45-degree field of view.
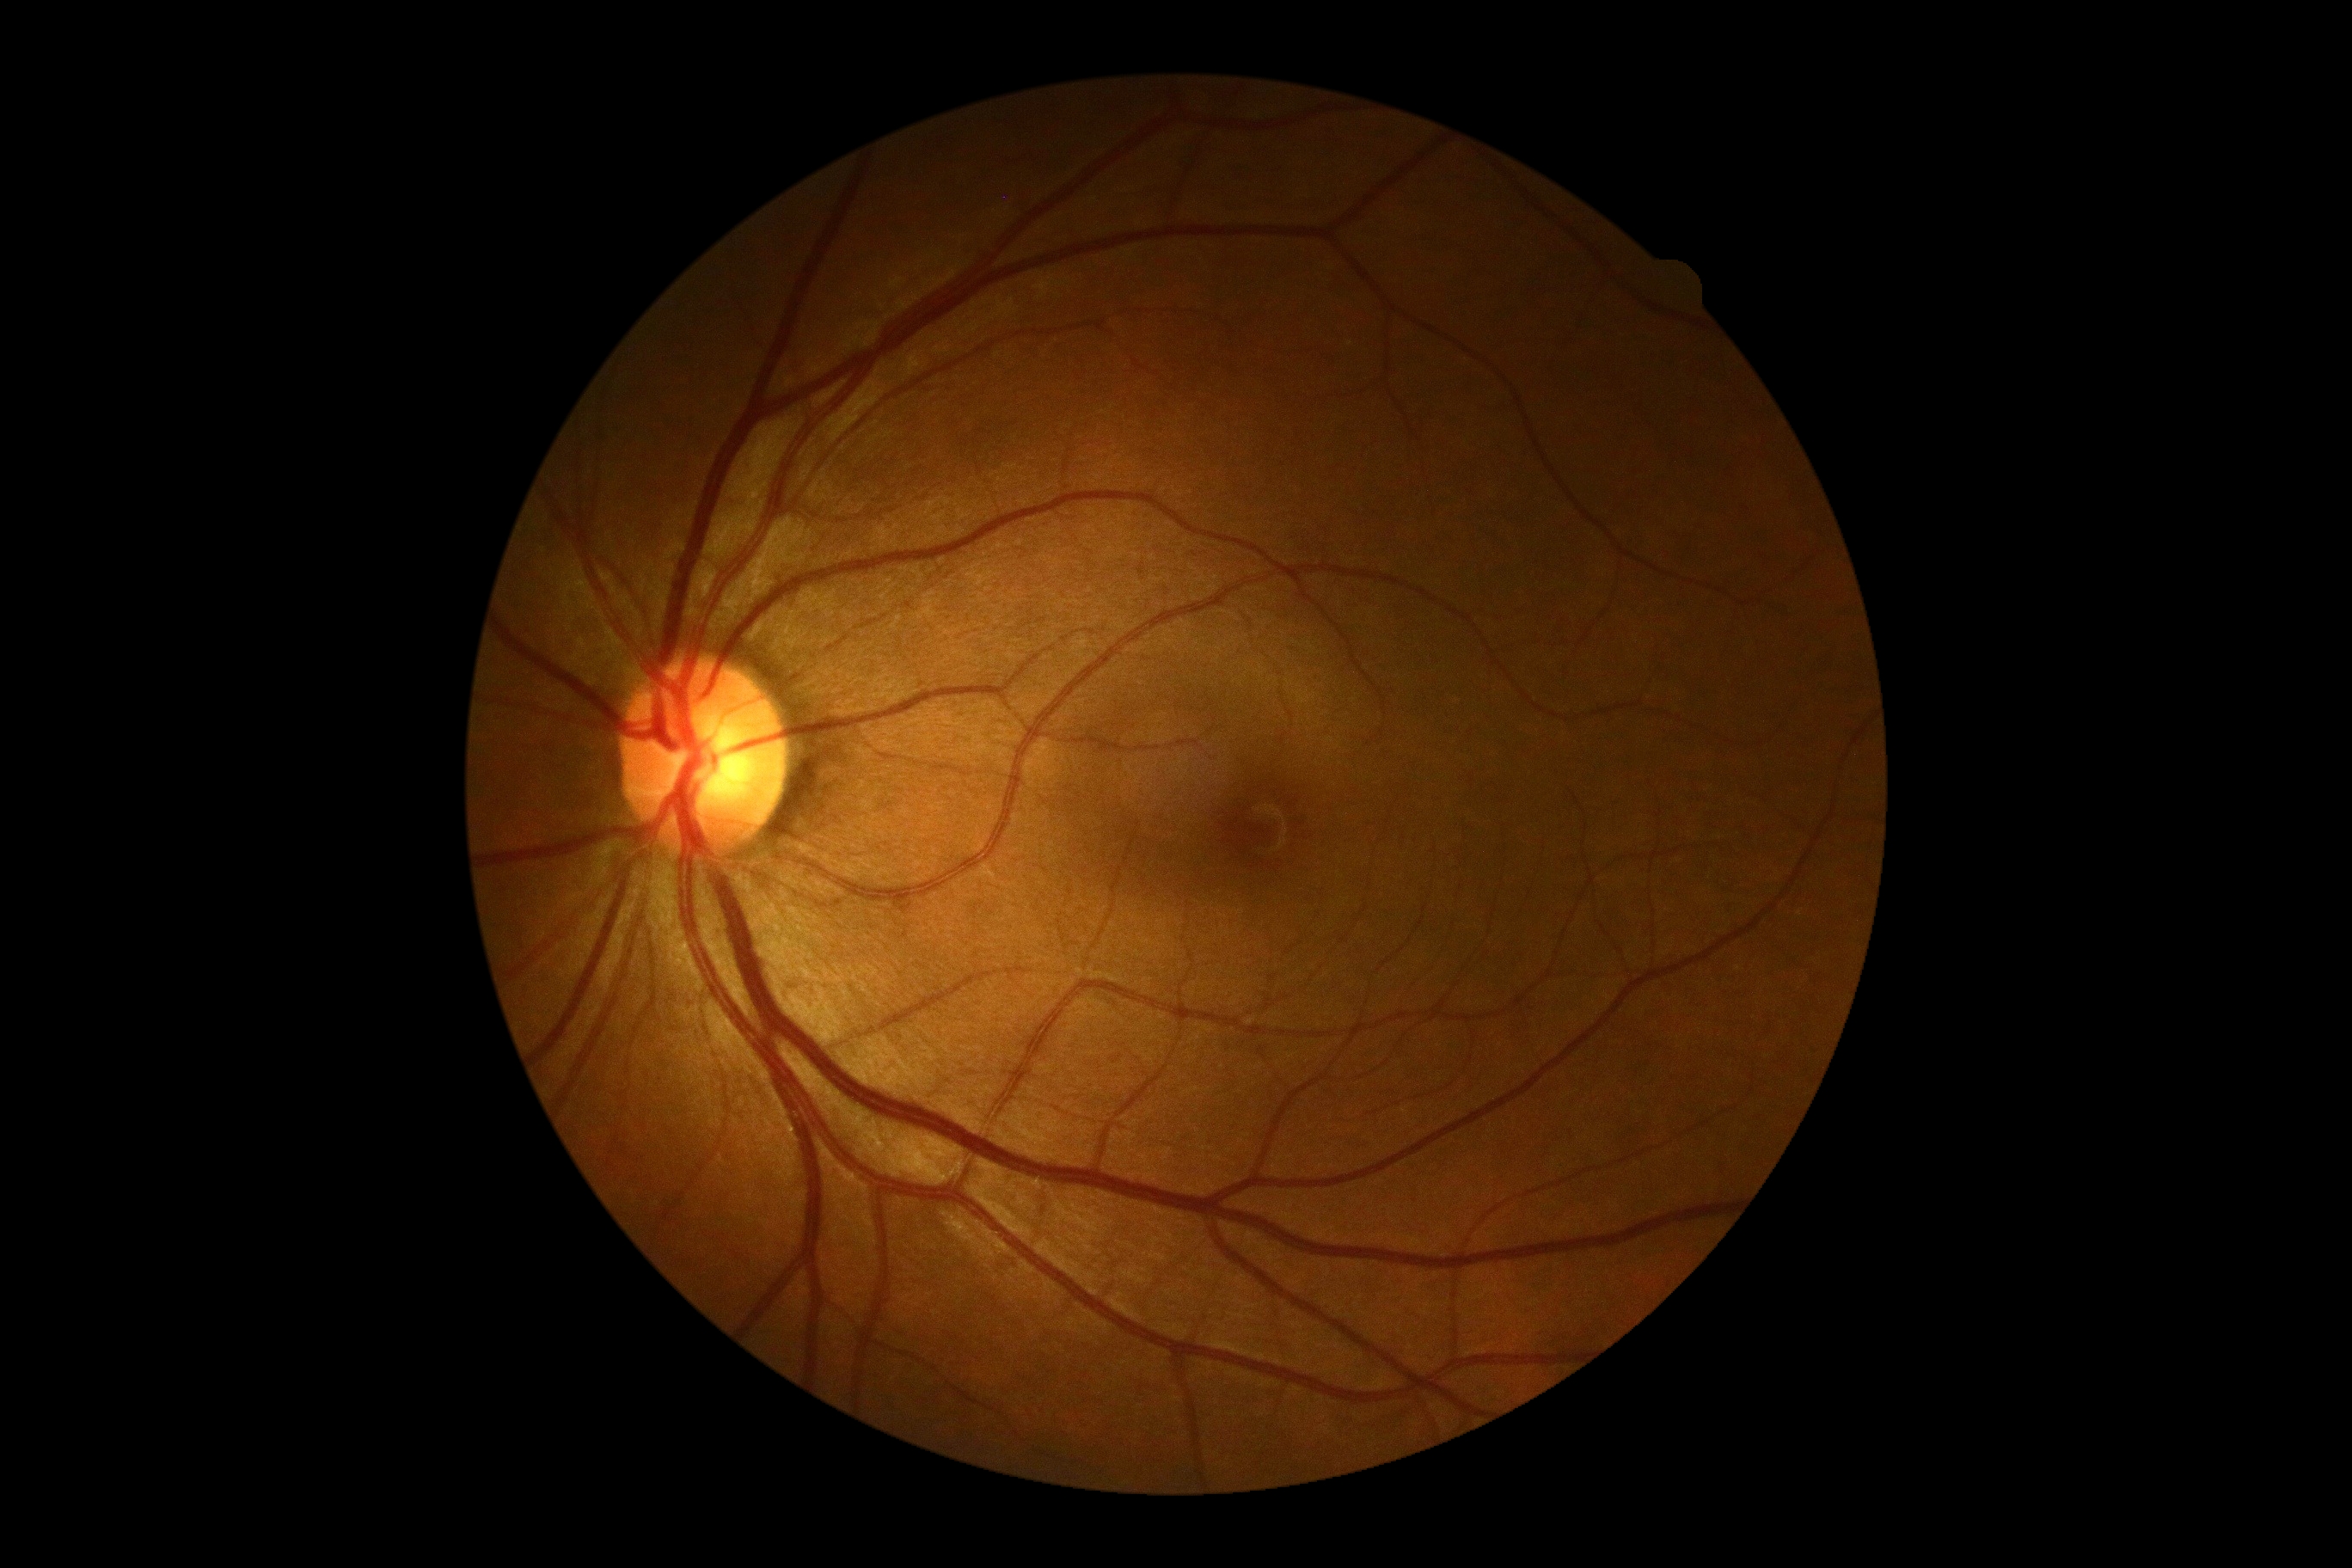 retinopathy grade@0 (no apparent retinopathy).